Nonmydriatic fundus photograph; fundus photo.
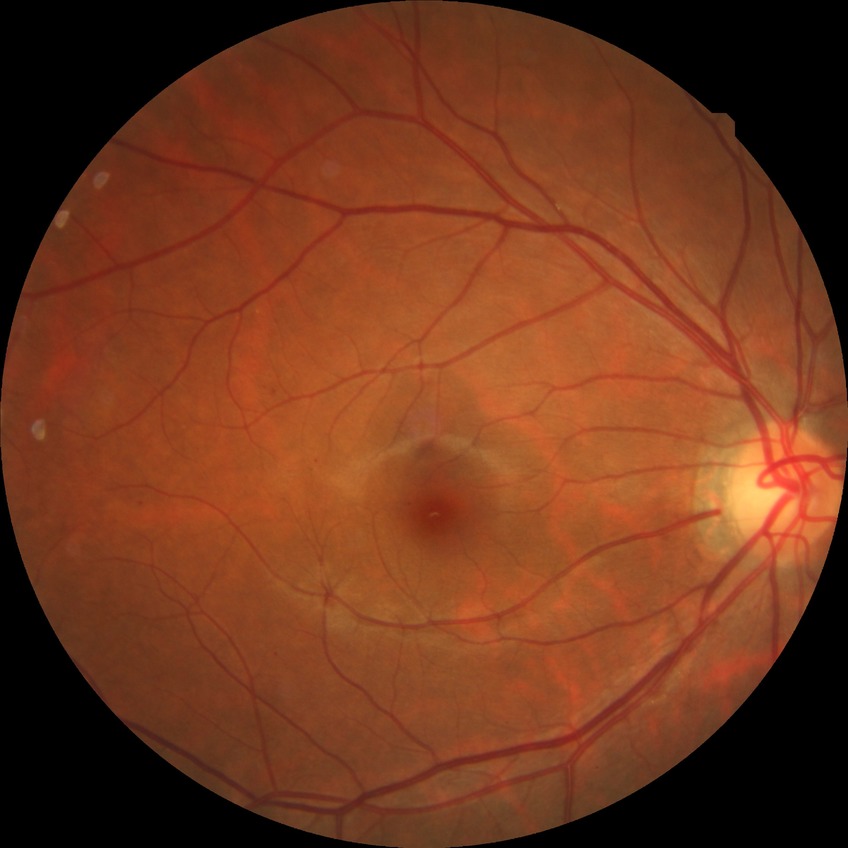

diabetic retinopathy (DR)=simple diabetic retinopathy (SDR).